45-degree field of view
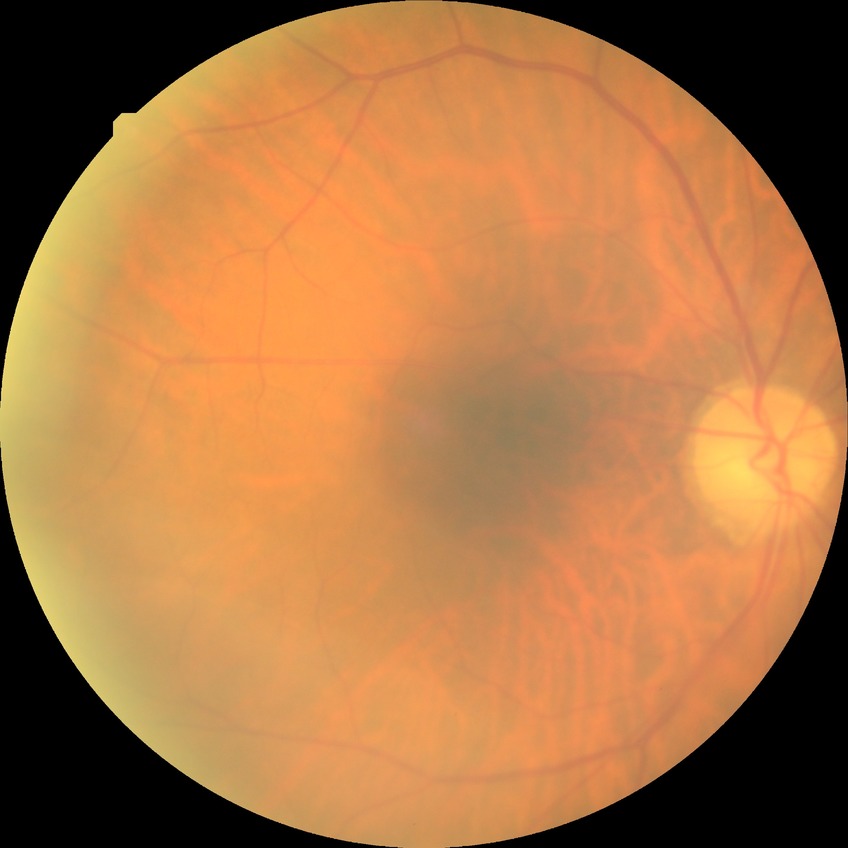
Davis grading: no diabetic retinopathy.